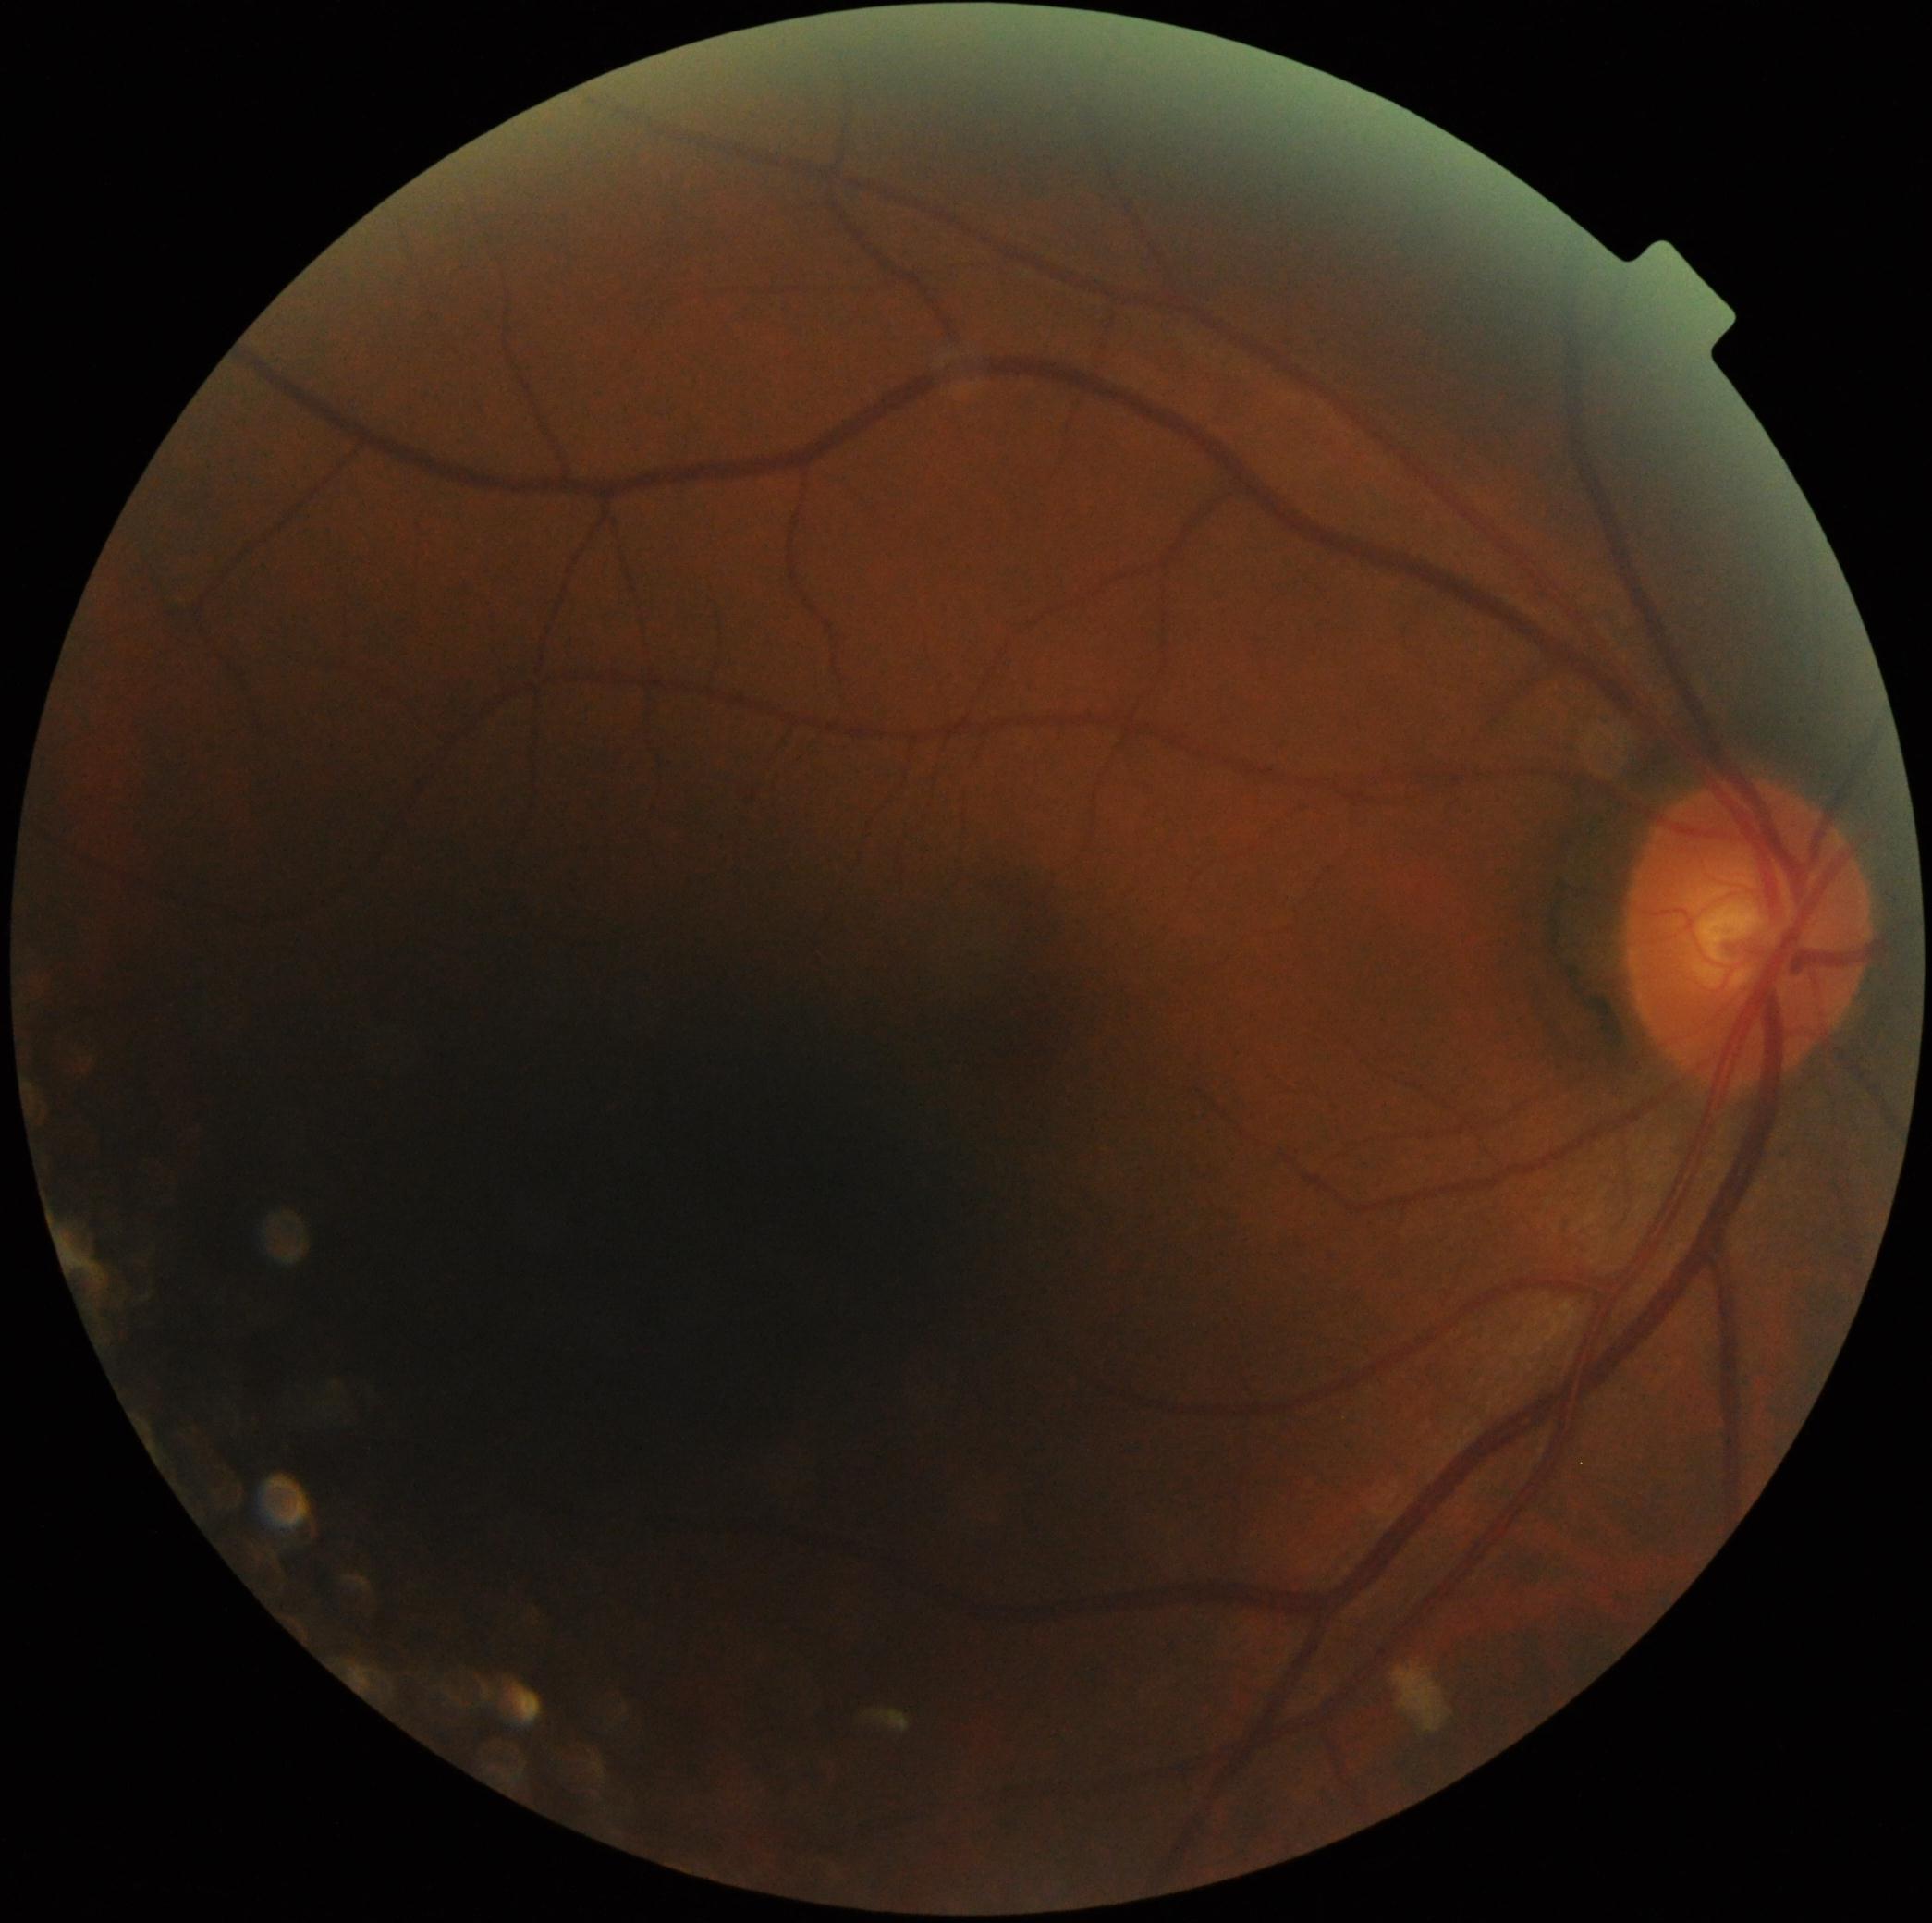

Diabetic retinopathy (DR) is 2 — more than just microaneurysms but less than severe NPDR.